Nidek AFC-330 · optic nerve head crop.
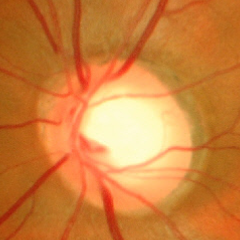

Glaucomatous optic neuropathy is present. Showing severe glaucomatous damage.